45-degree field of view; 2212 by 1659 pixels — 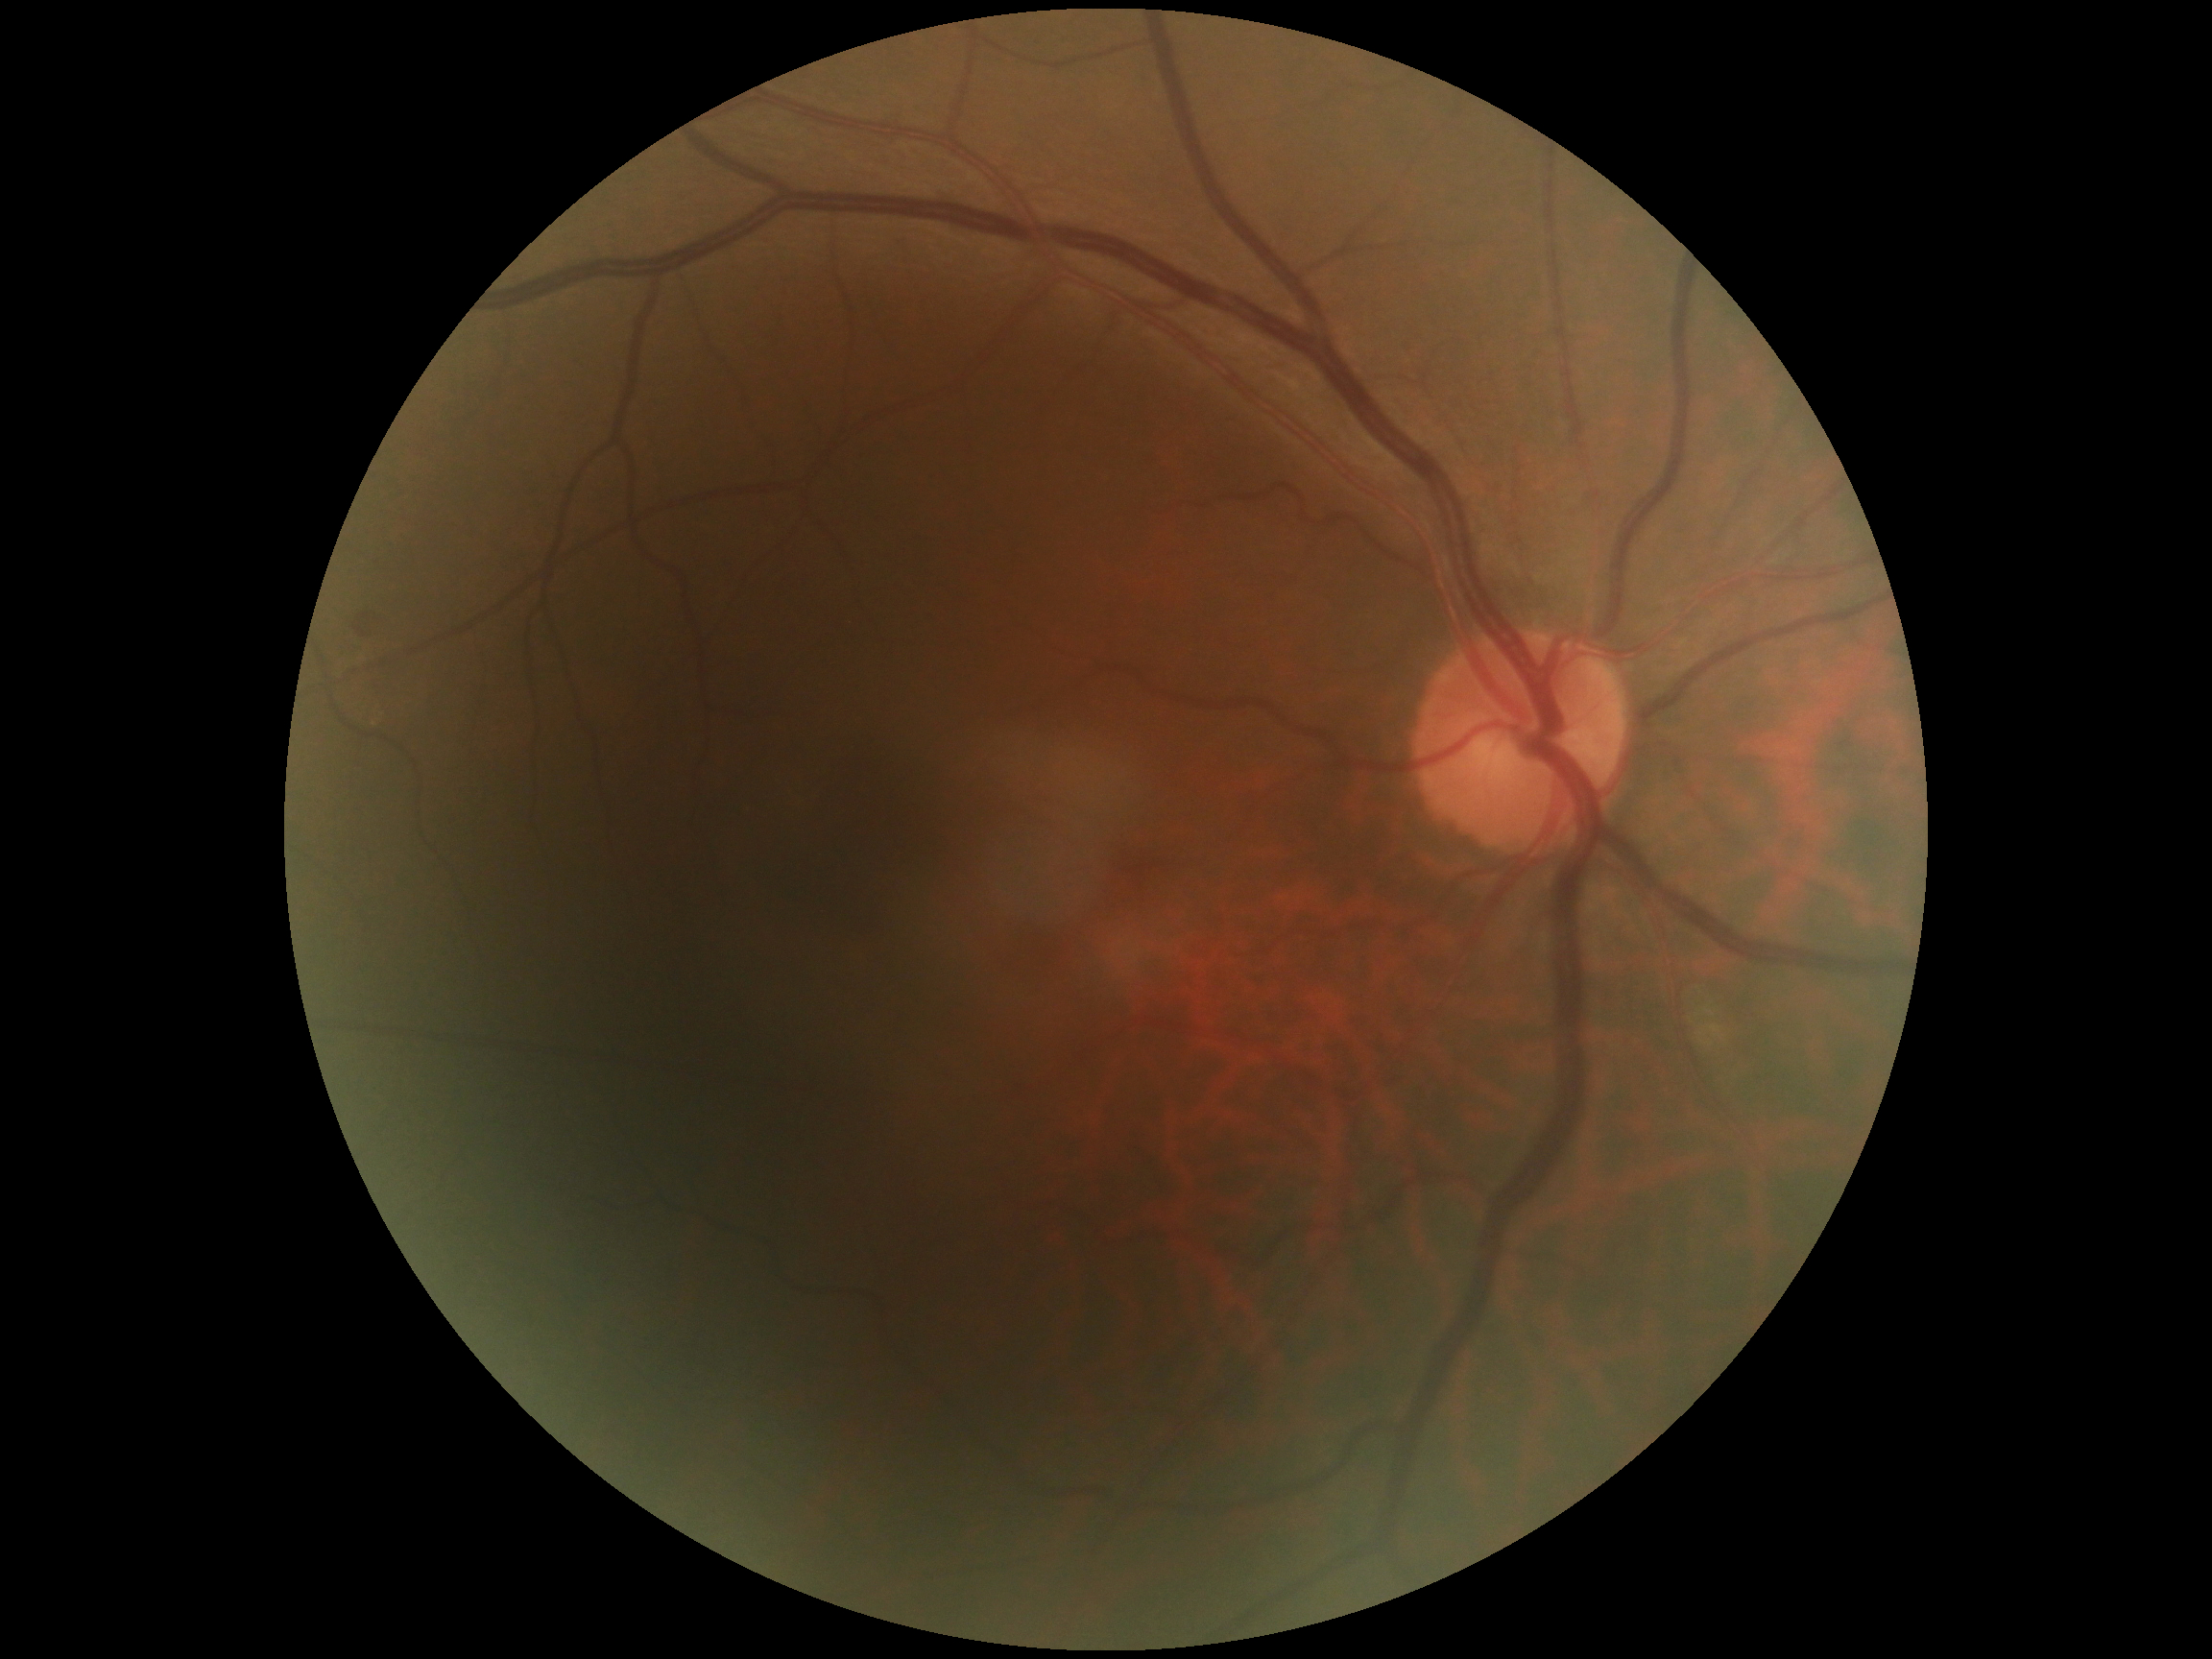

  dr_grade: grade 0 (no apparent retinopathy)